45-degree field of view · DR severity per modified Davis staging
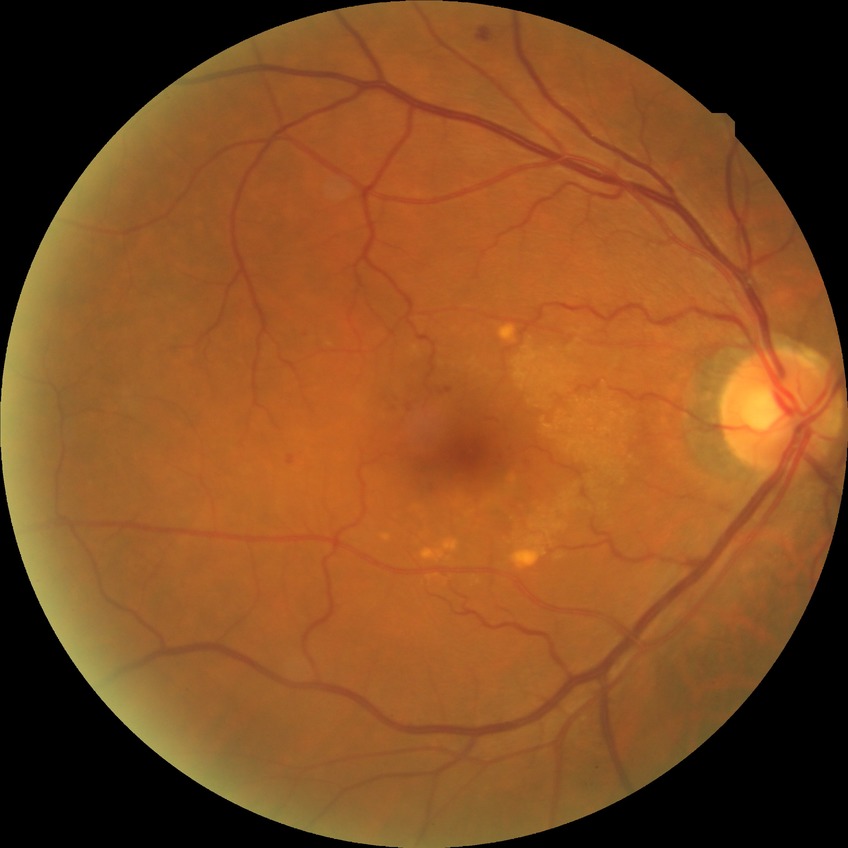 Diabetic retinopathy (DR) is PPDR (pre-proliferative diabetic retinopathy).